Color fundus photograph
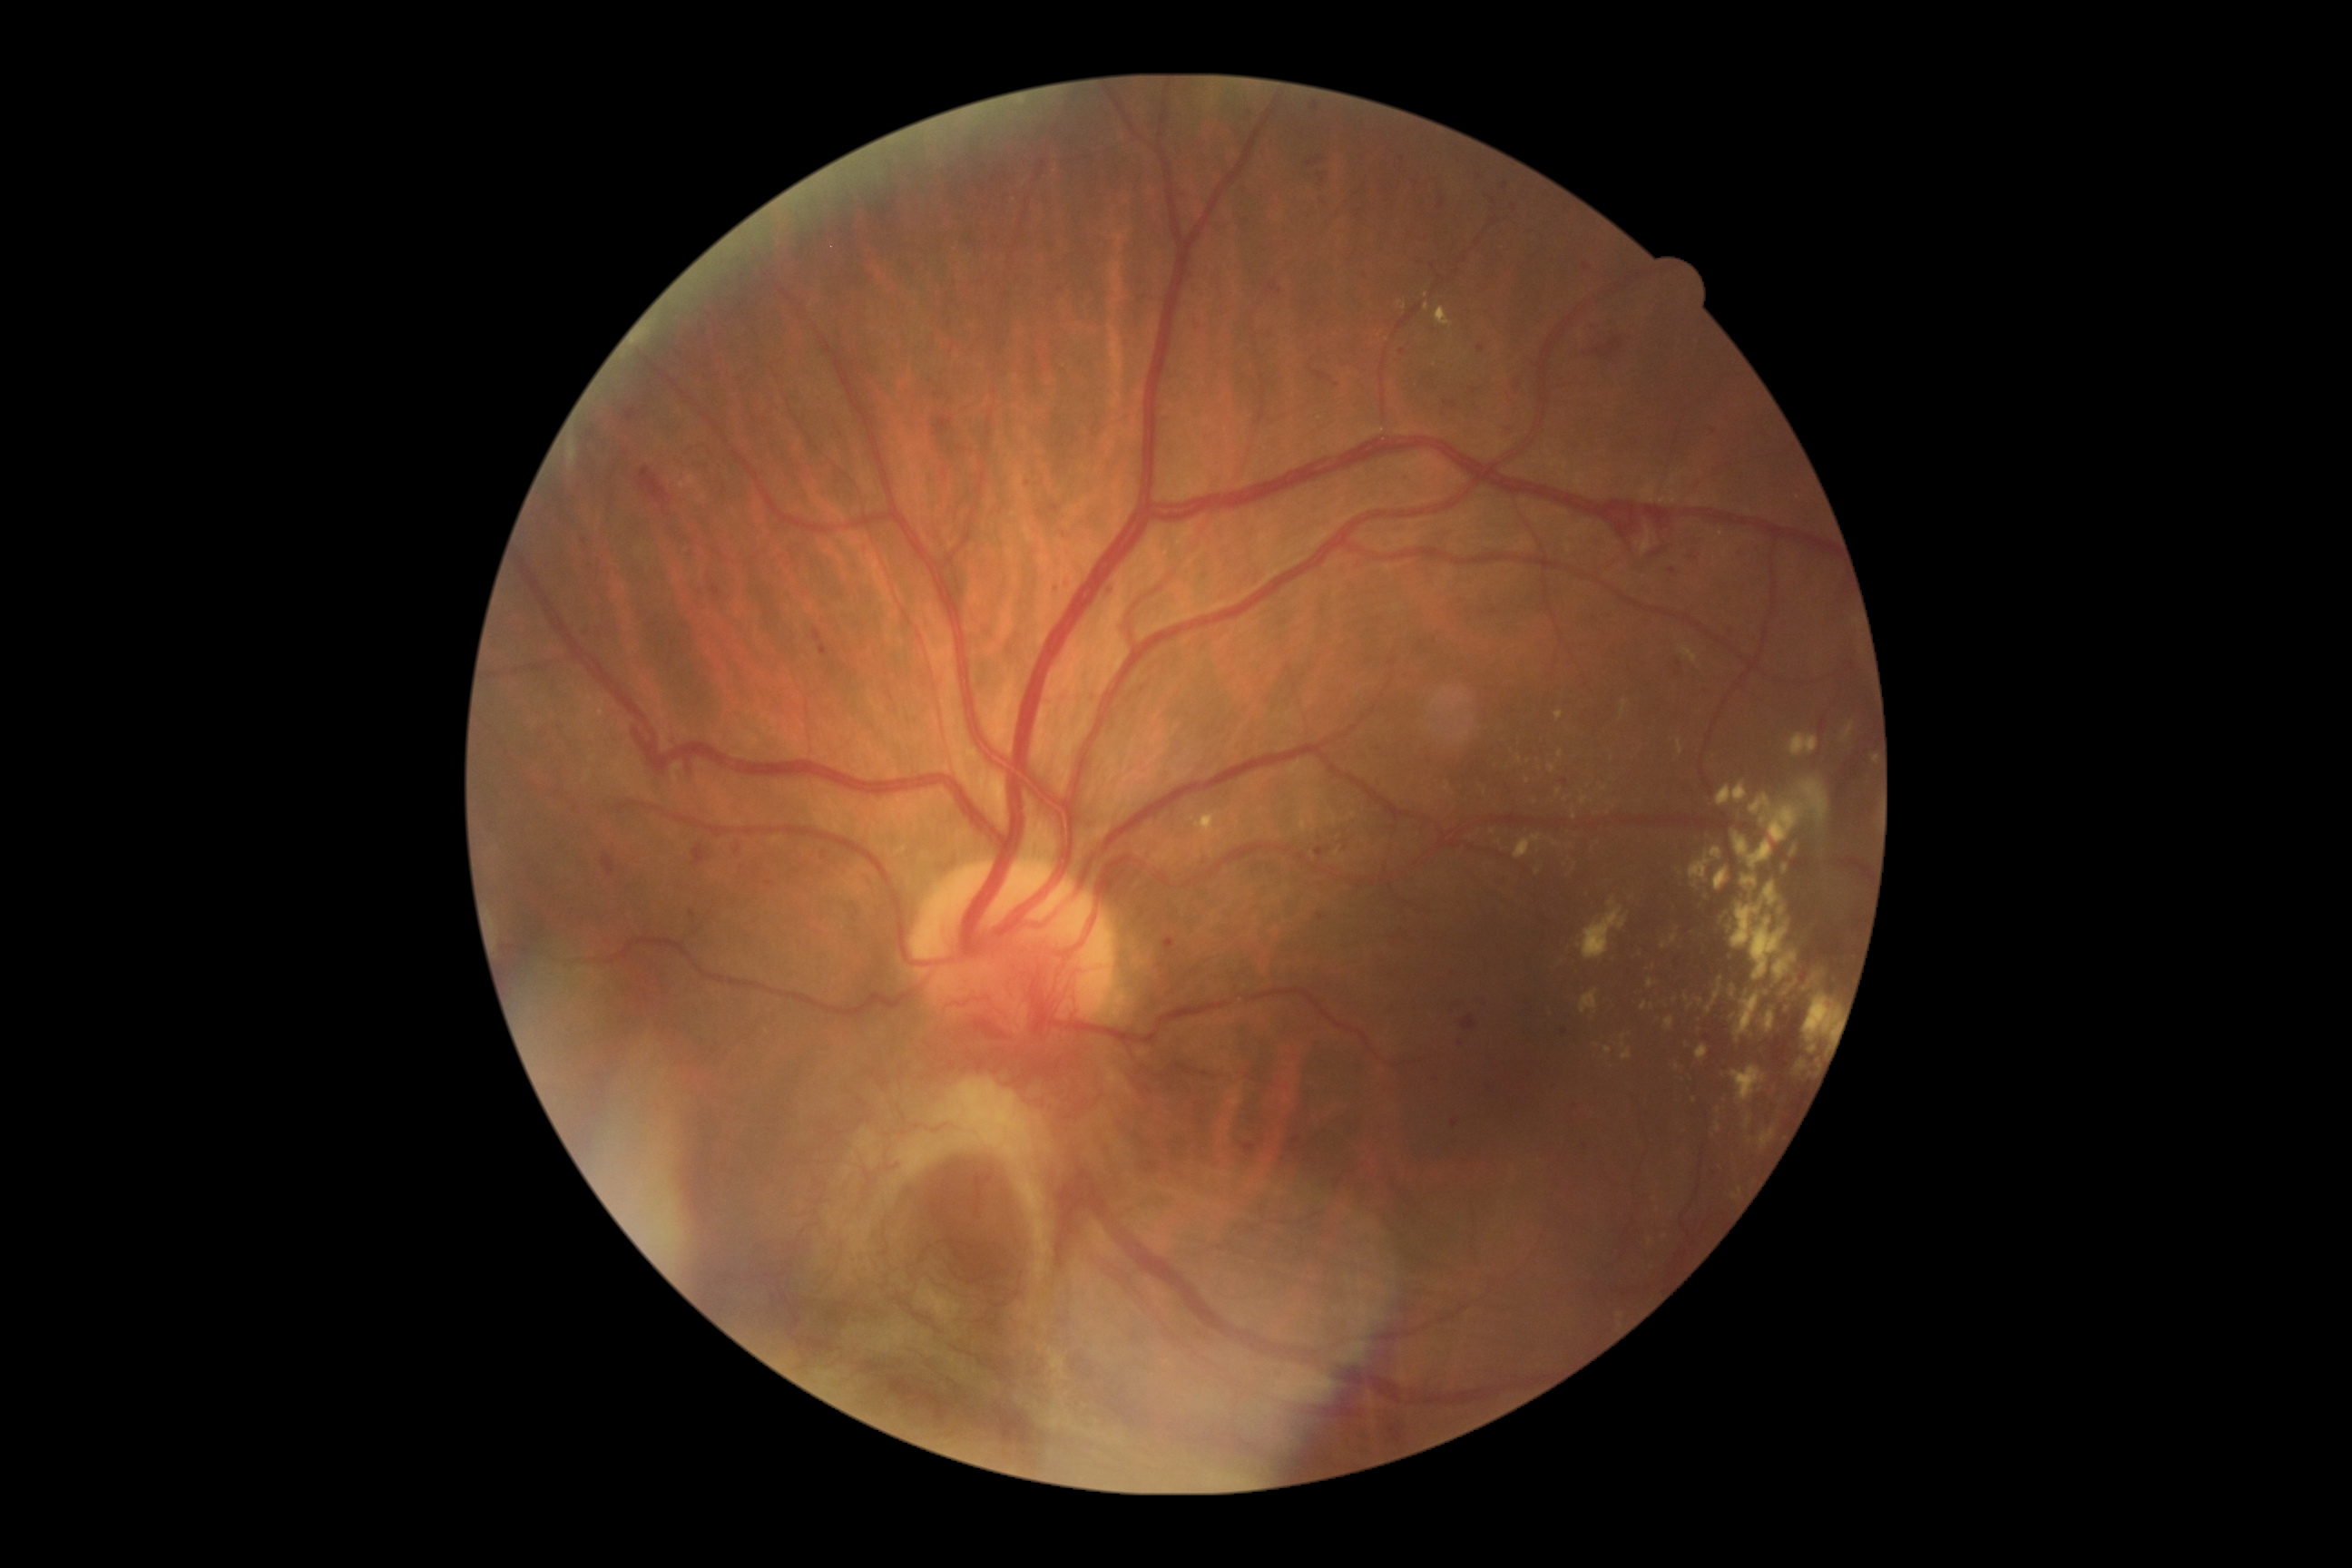 Diabetic retinopathy is 4/4.
DR class: proliferative diabetic retinopathy.